CFP · 1932 by 1932 pixels — 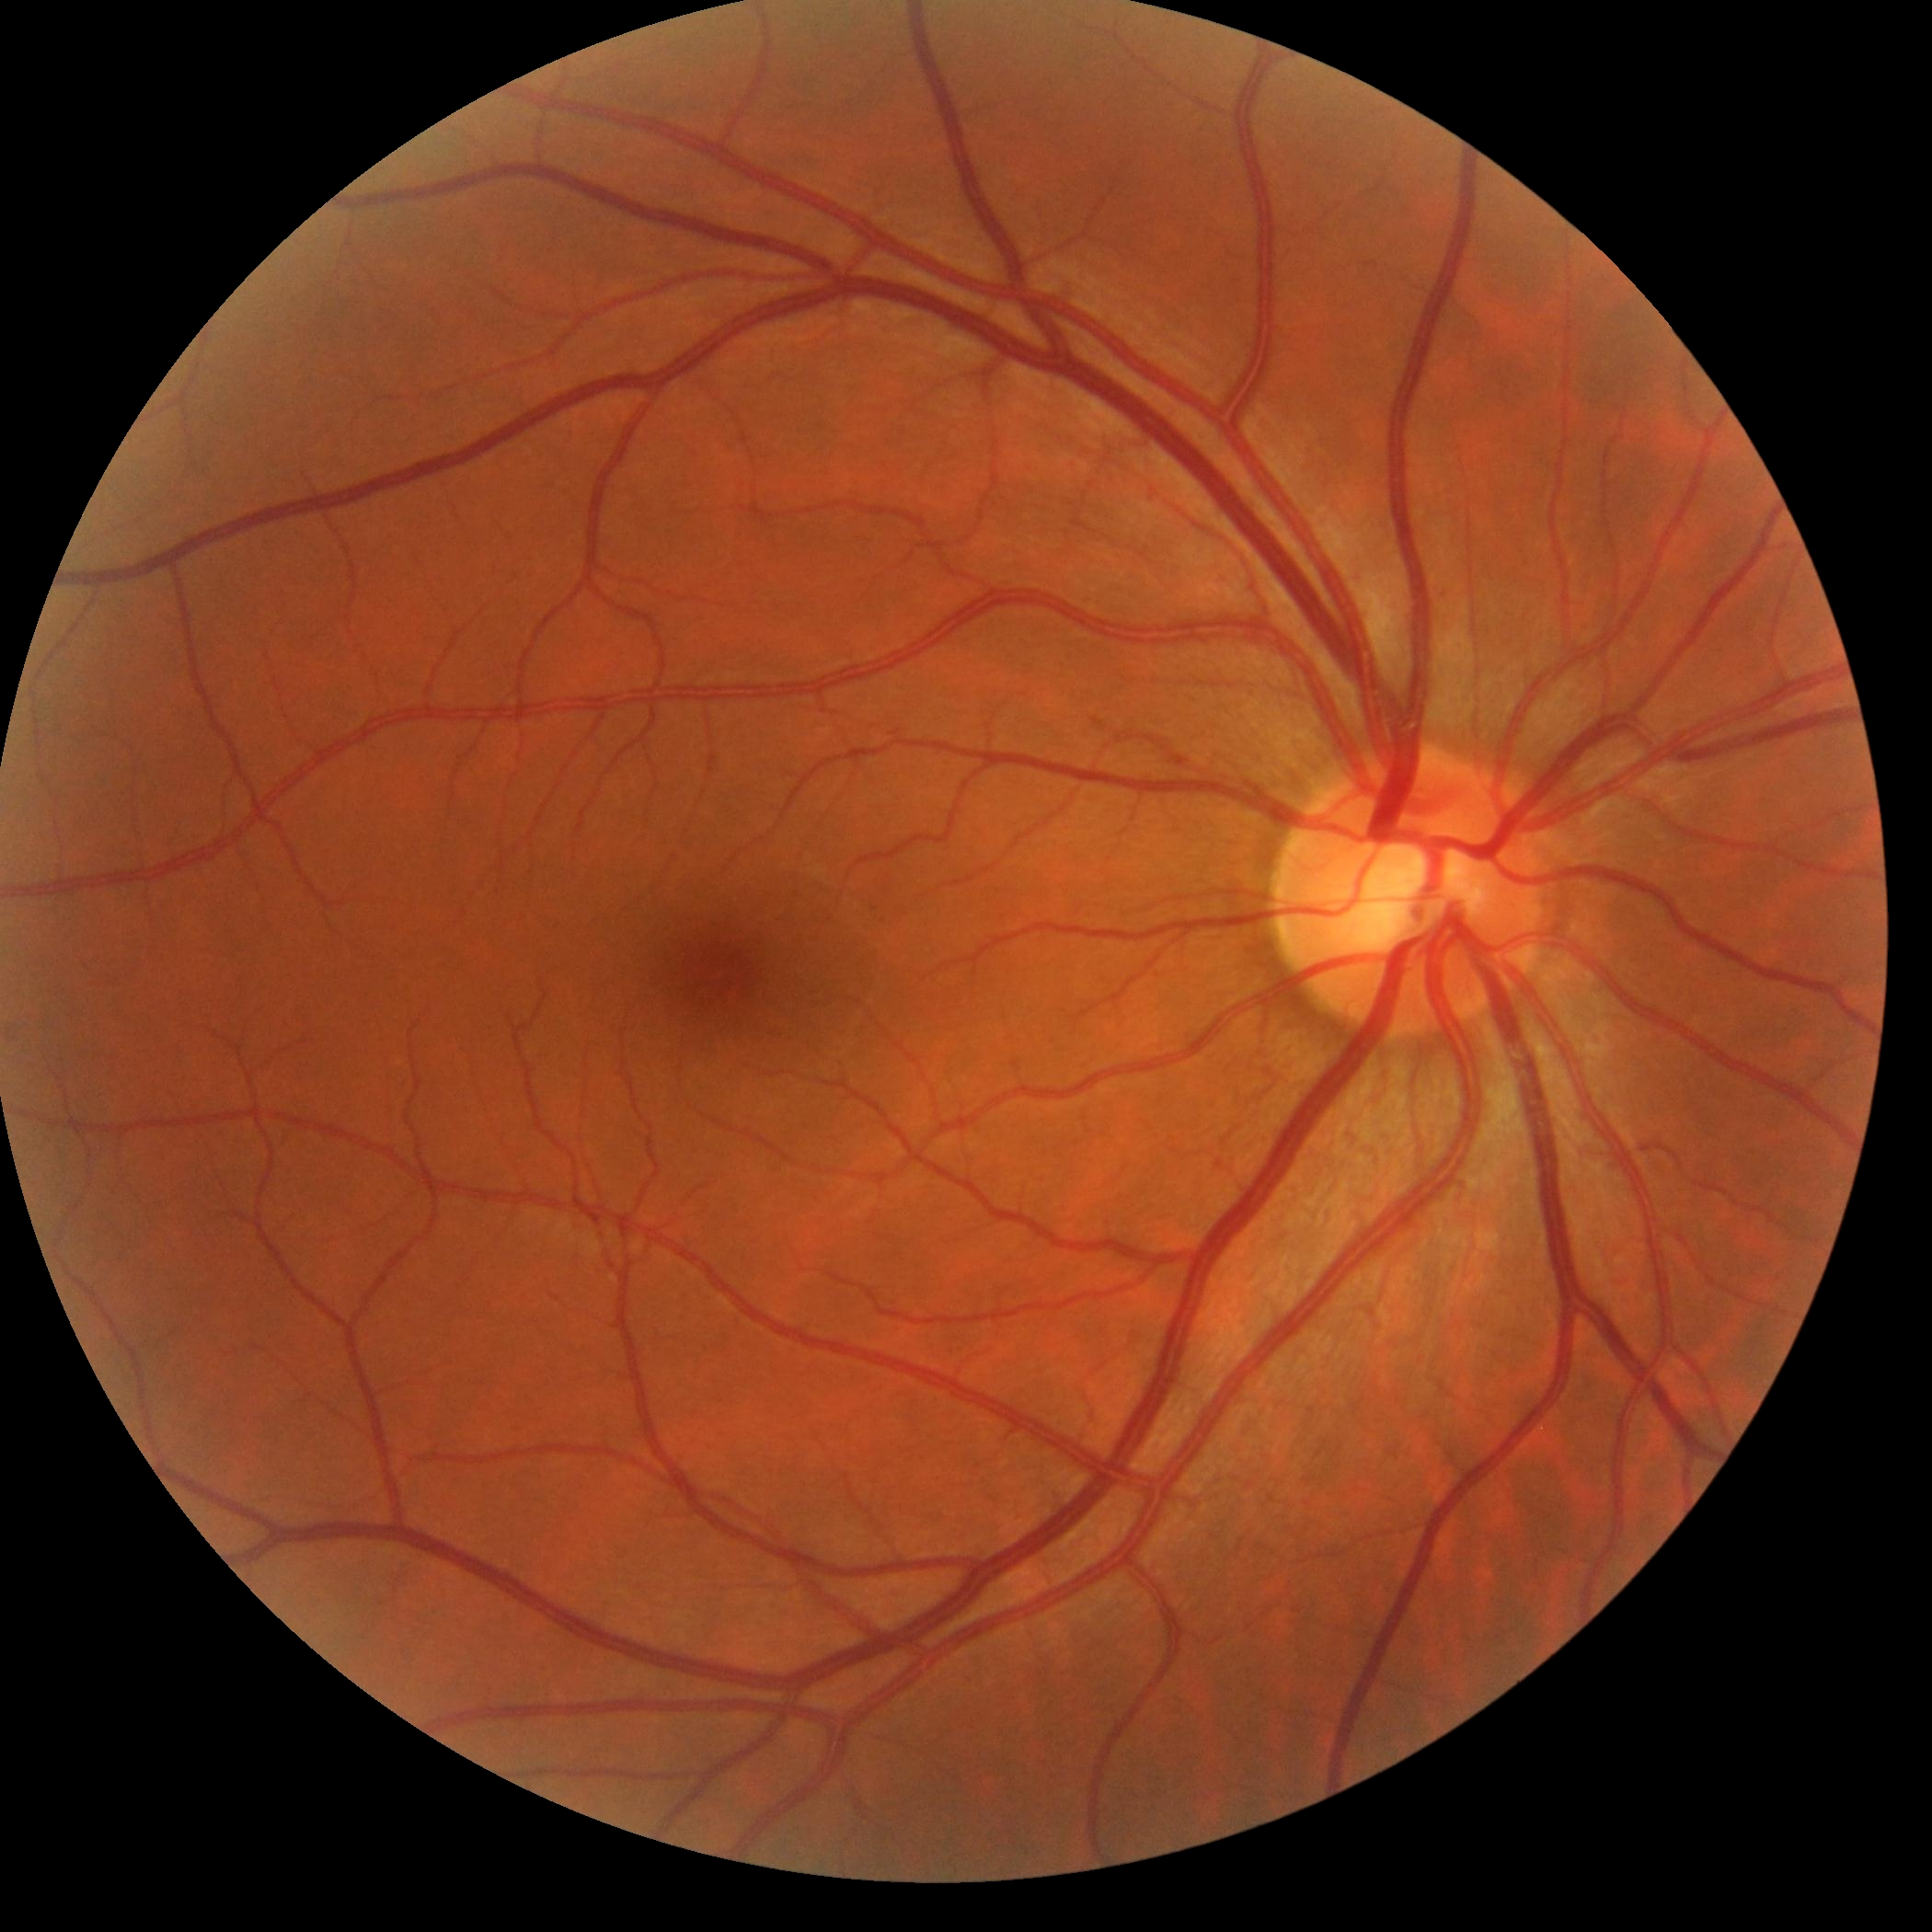 No apparent diabetic retinopathy. Retinopathy grade: 0 (no apparent retinopathy).